Pediatric wide-field fundus photograph; Clarity RetCam 3, 130° FOV
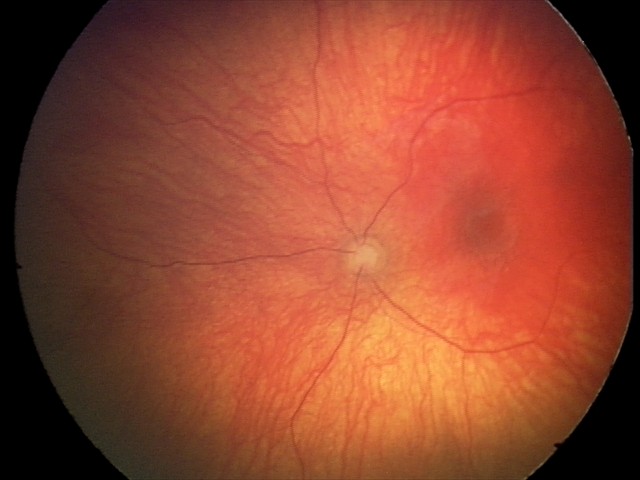

Finding: optic nerve hypoplasia.